CFP — 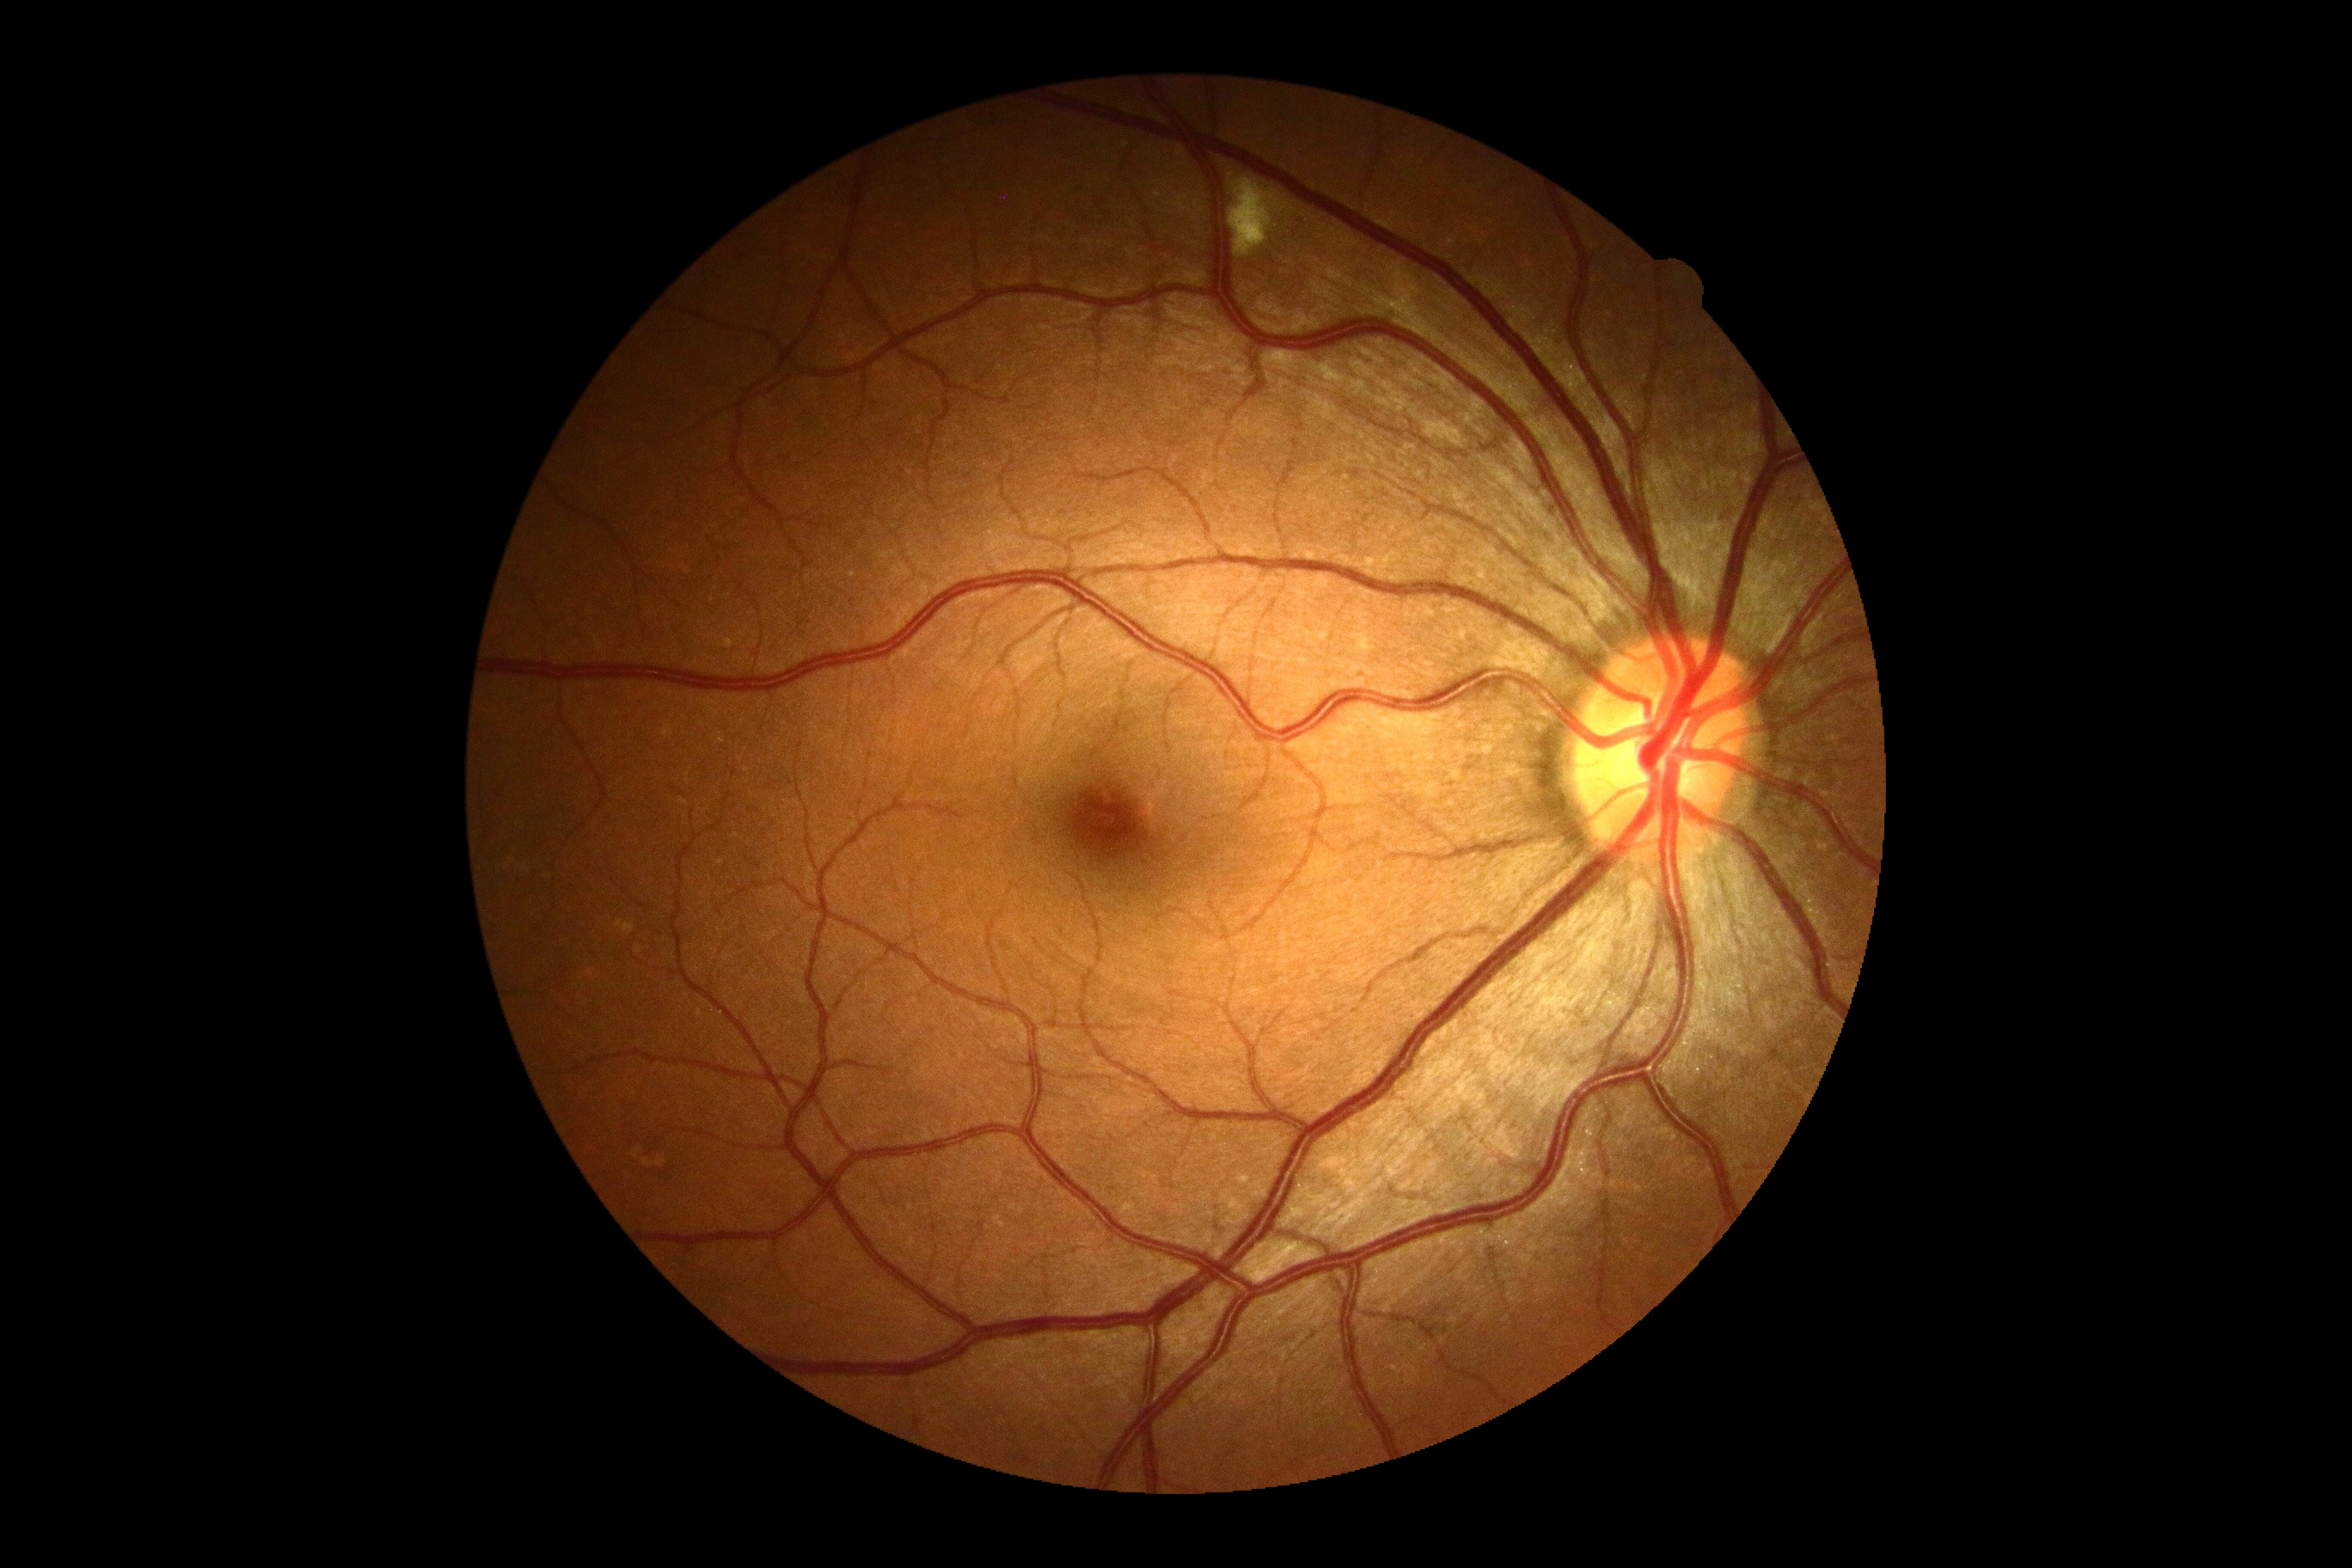 DR stage: 2/4.